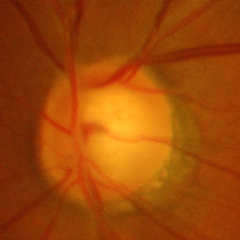 Glaucoma diagnosis: advanced-stage glaucoma.